45° FOV:
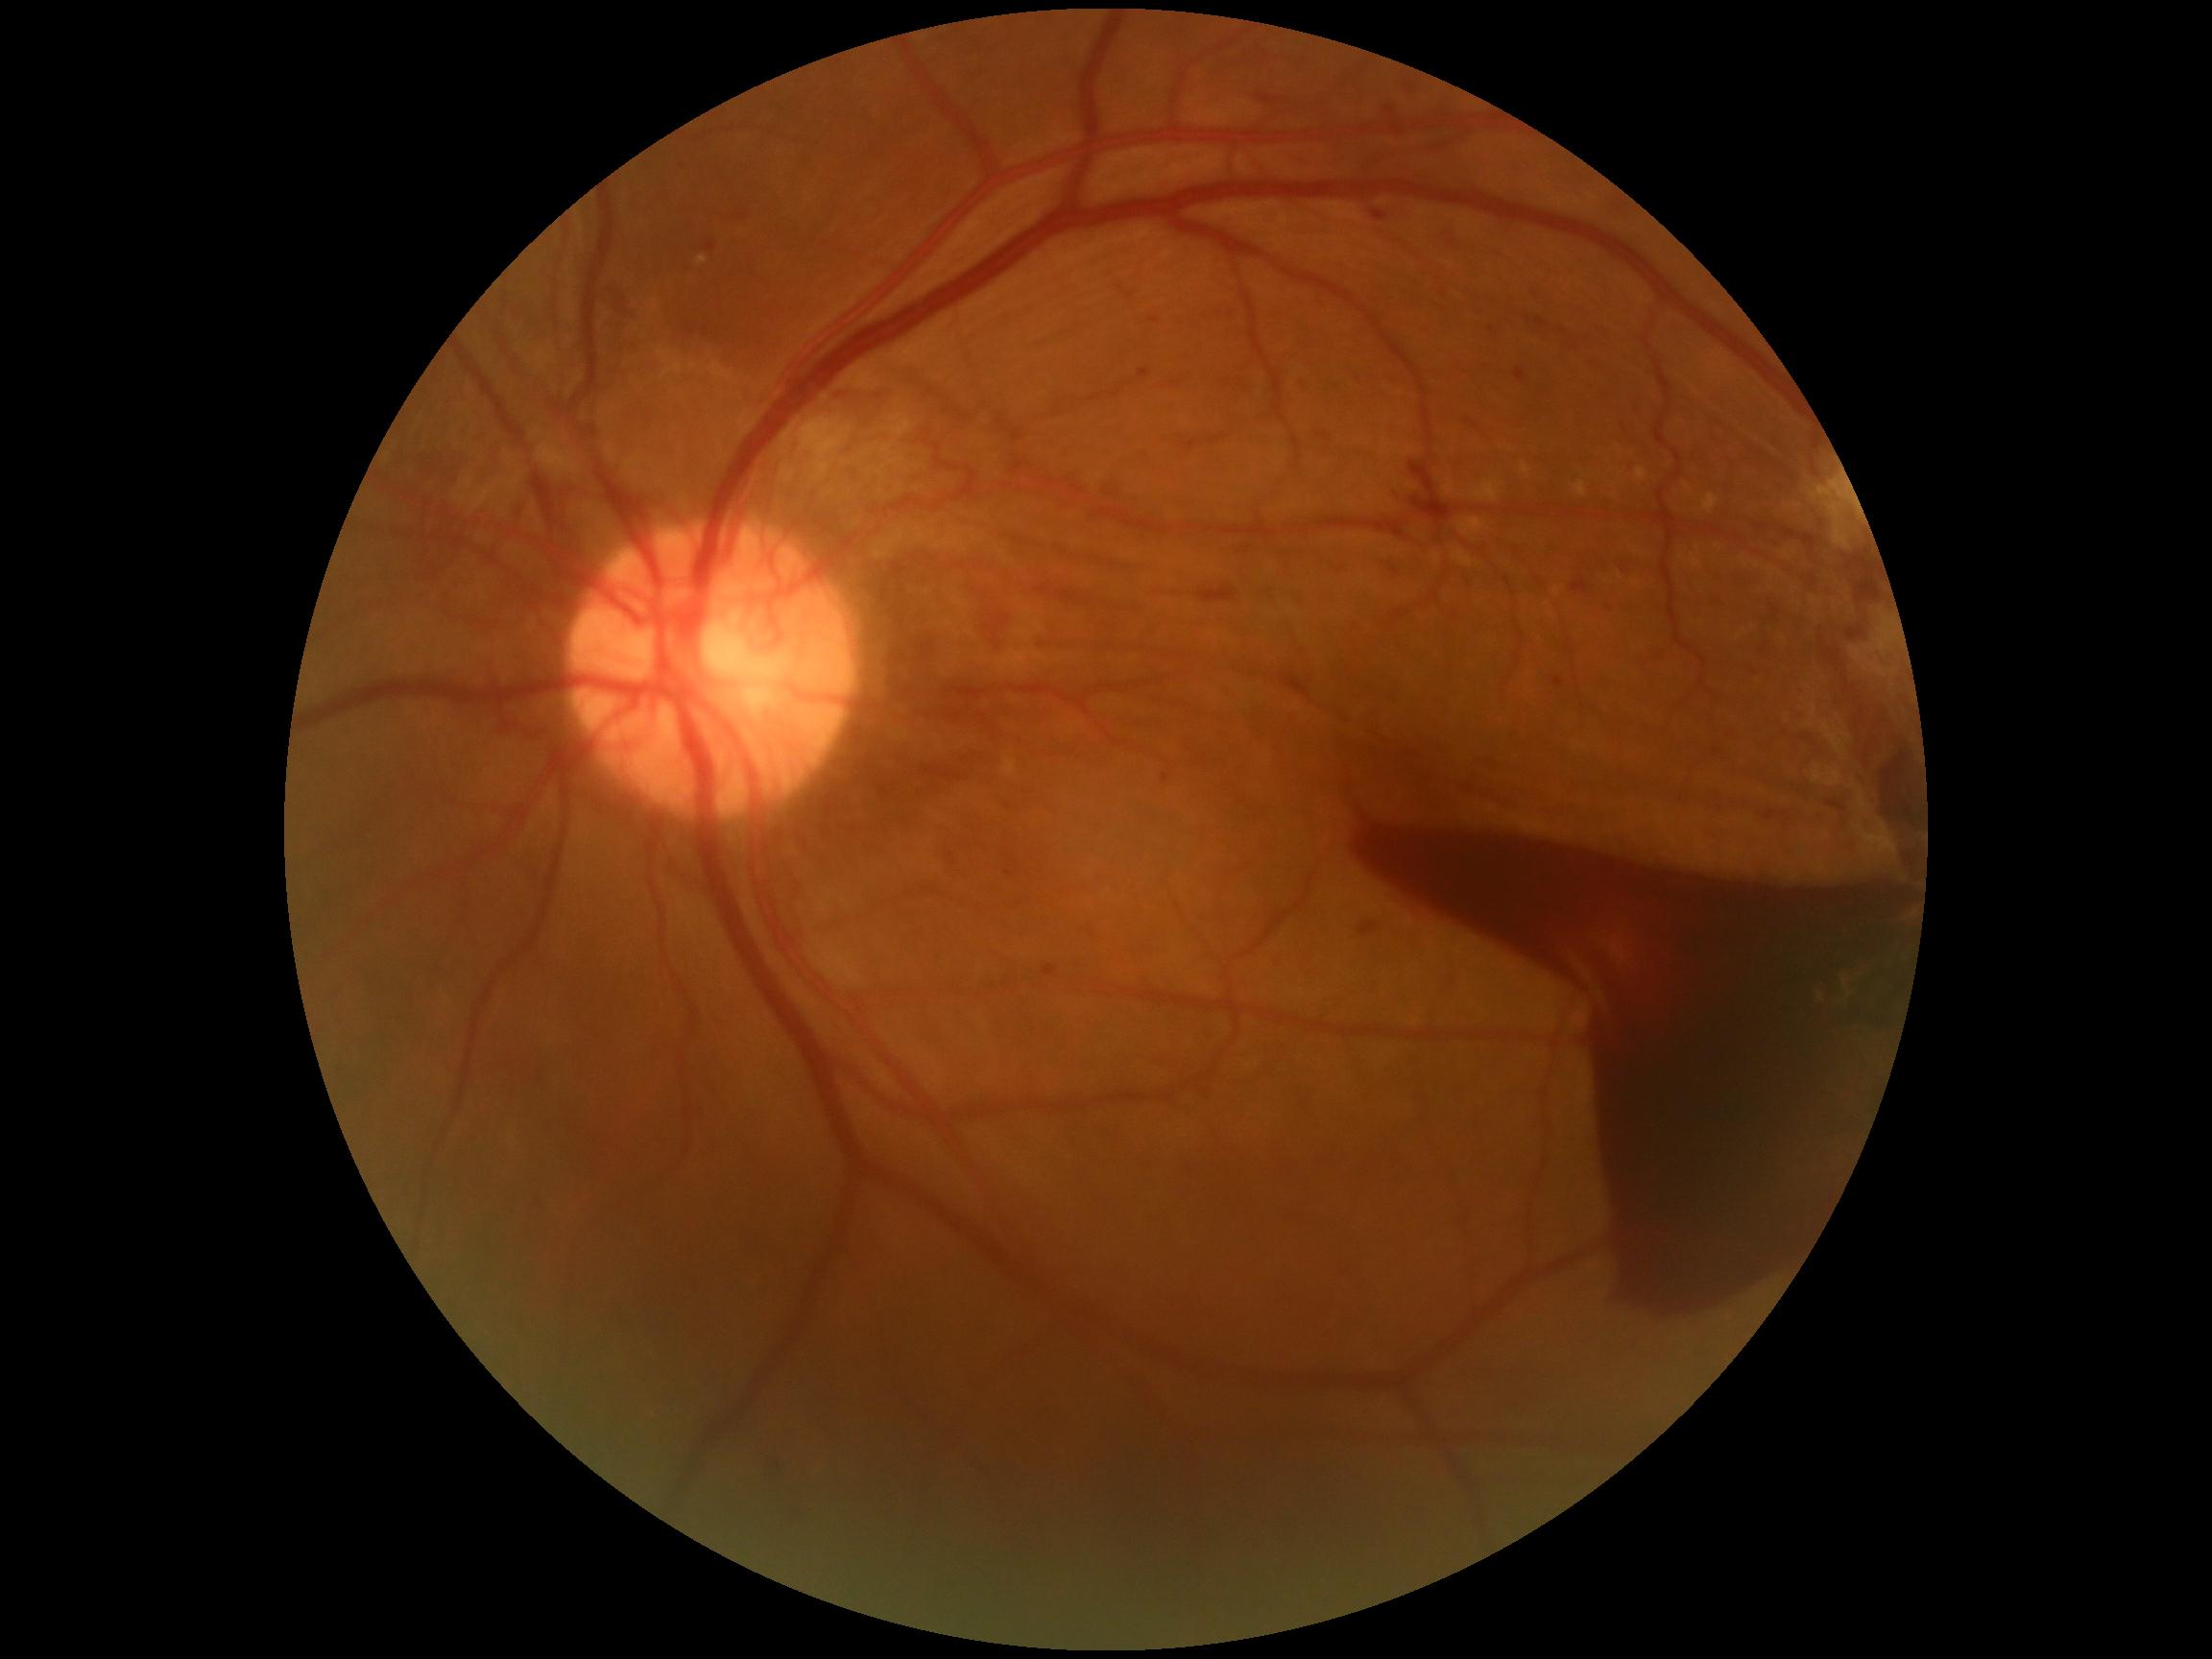 Annotations:
* retinopathy grade — 4/4